2048x1536
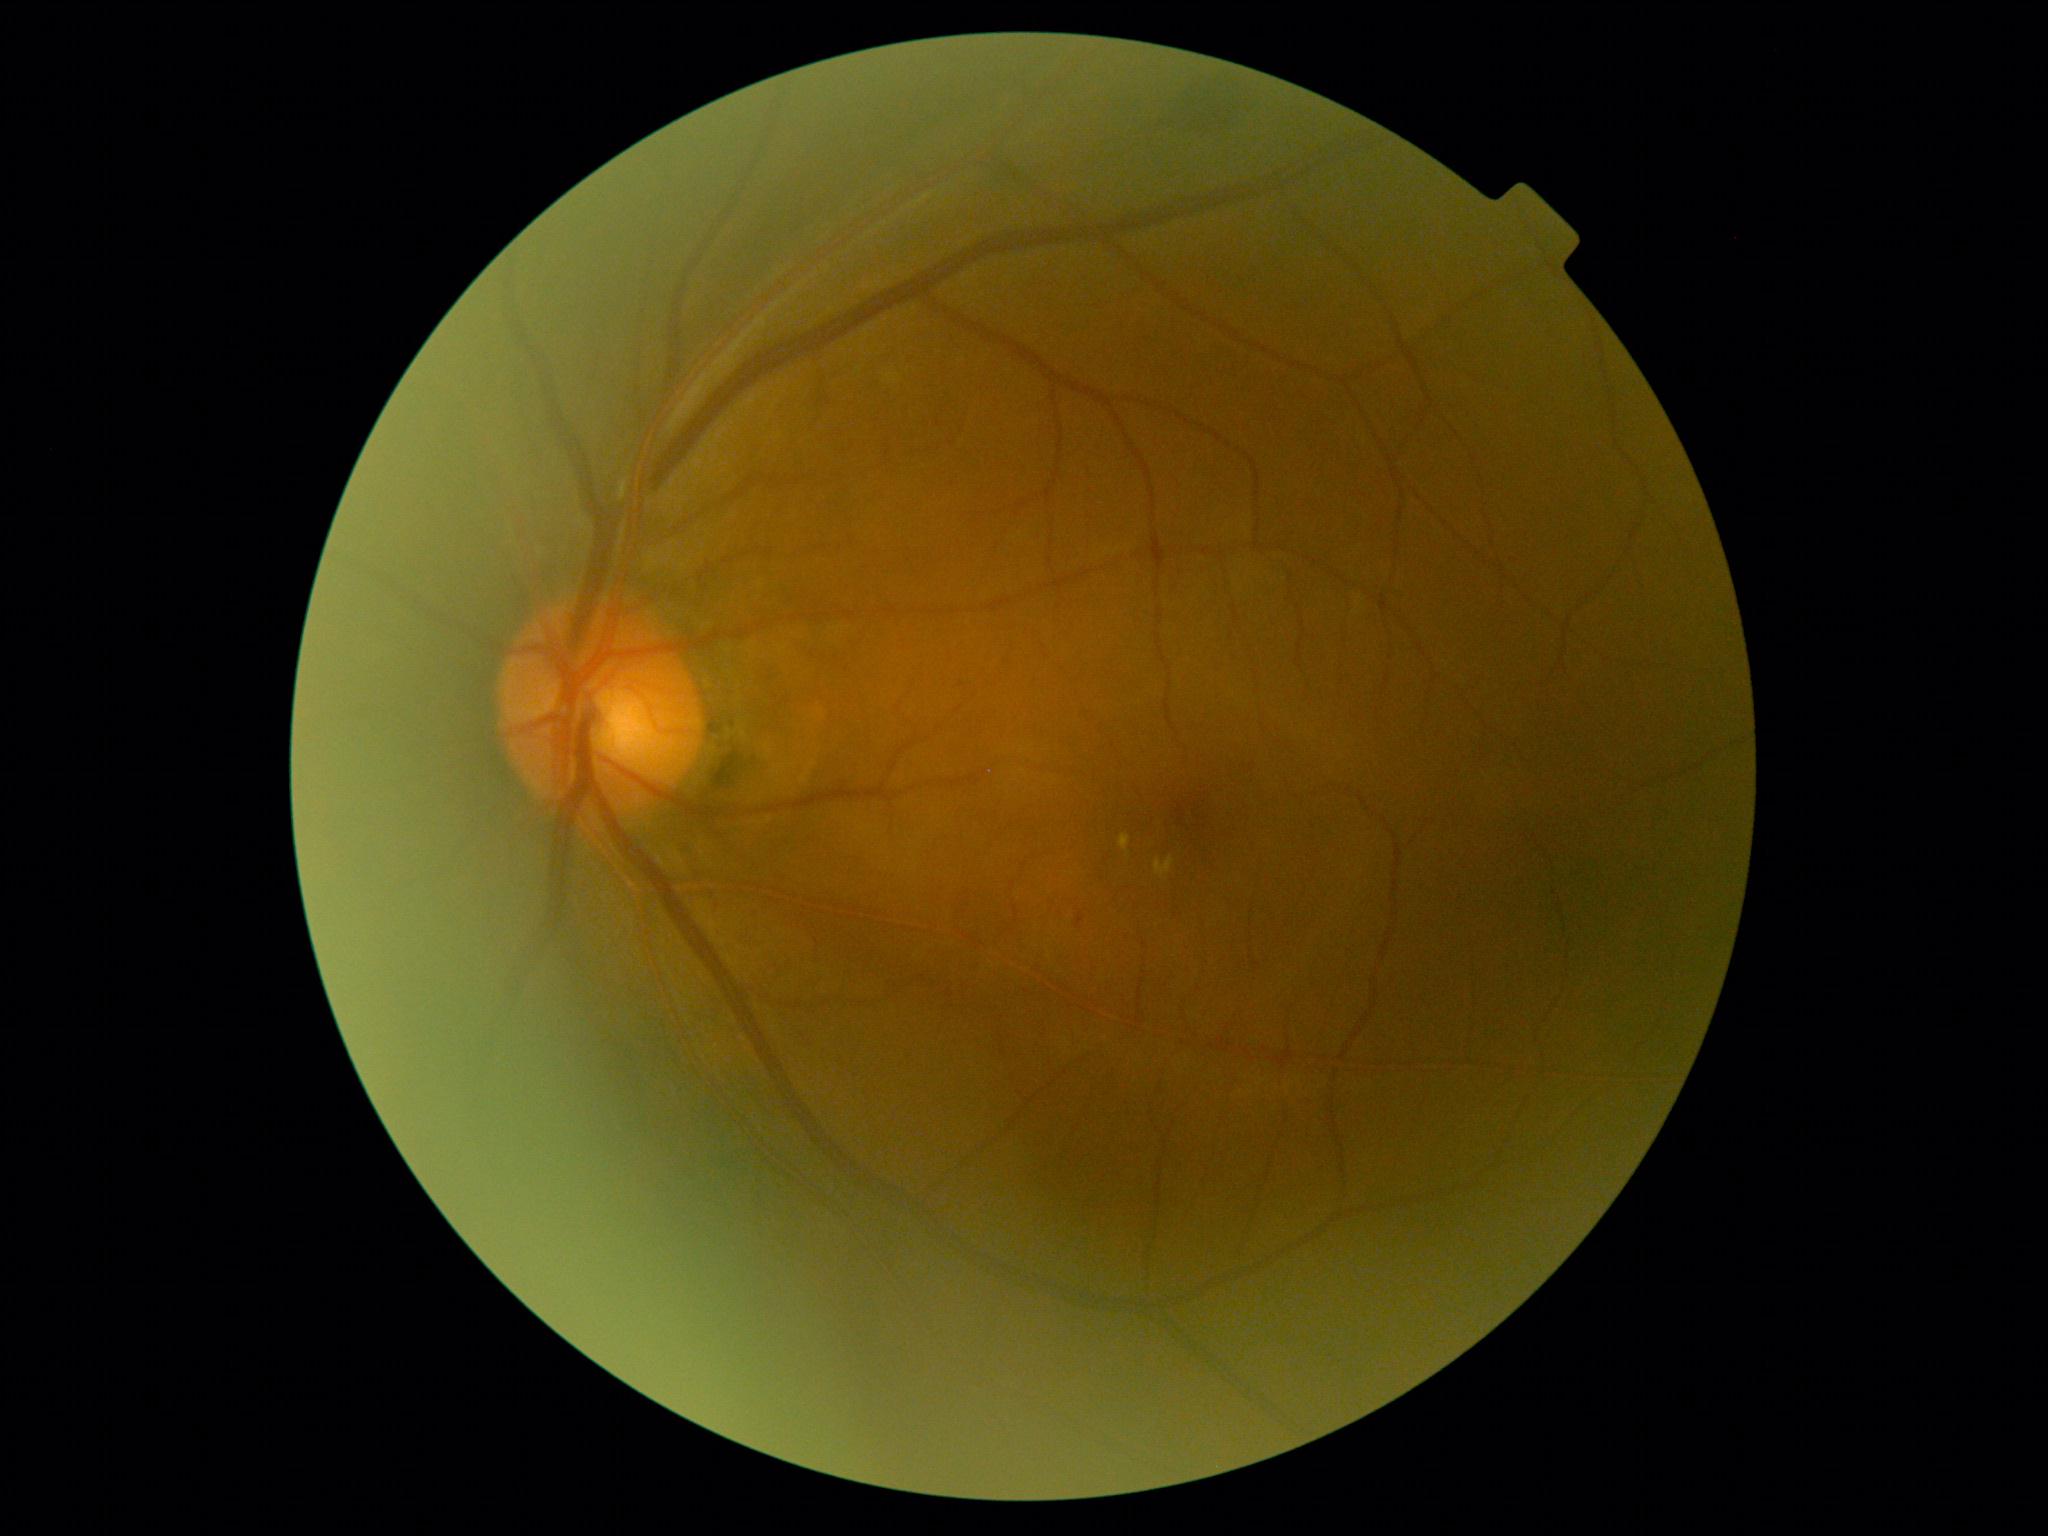 Diabetic retinopathy grade is 2 (moderate NPDR).